NIDEK AFC-230.
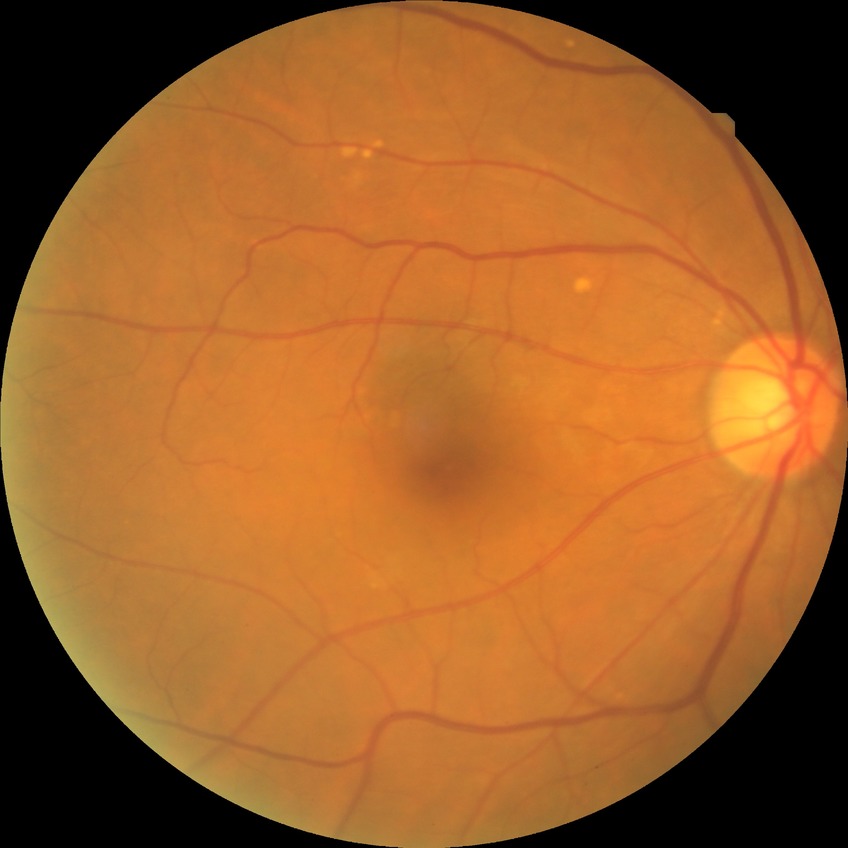

Diabetic retinopathy (DR): no diabetic retinopathy (NDR).